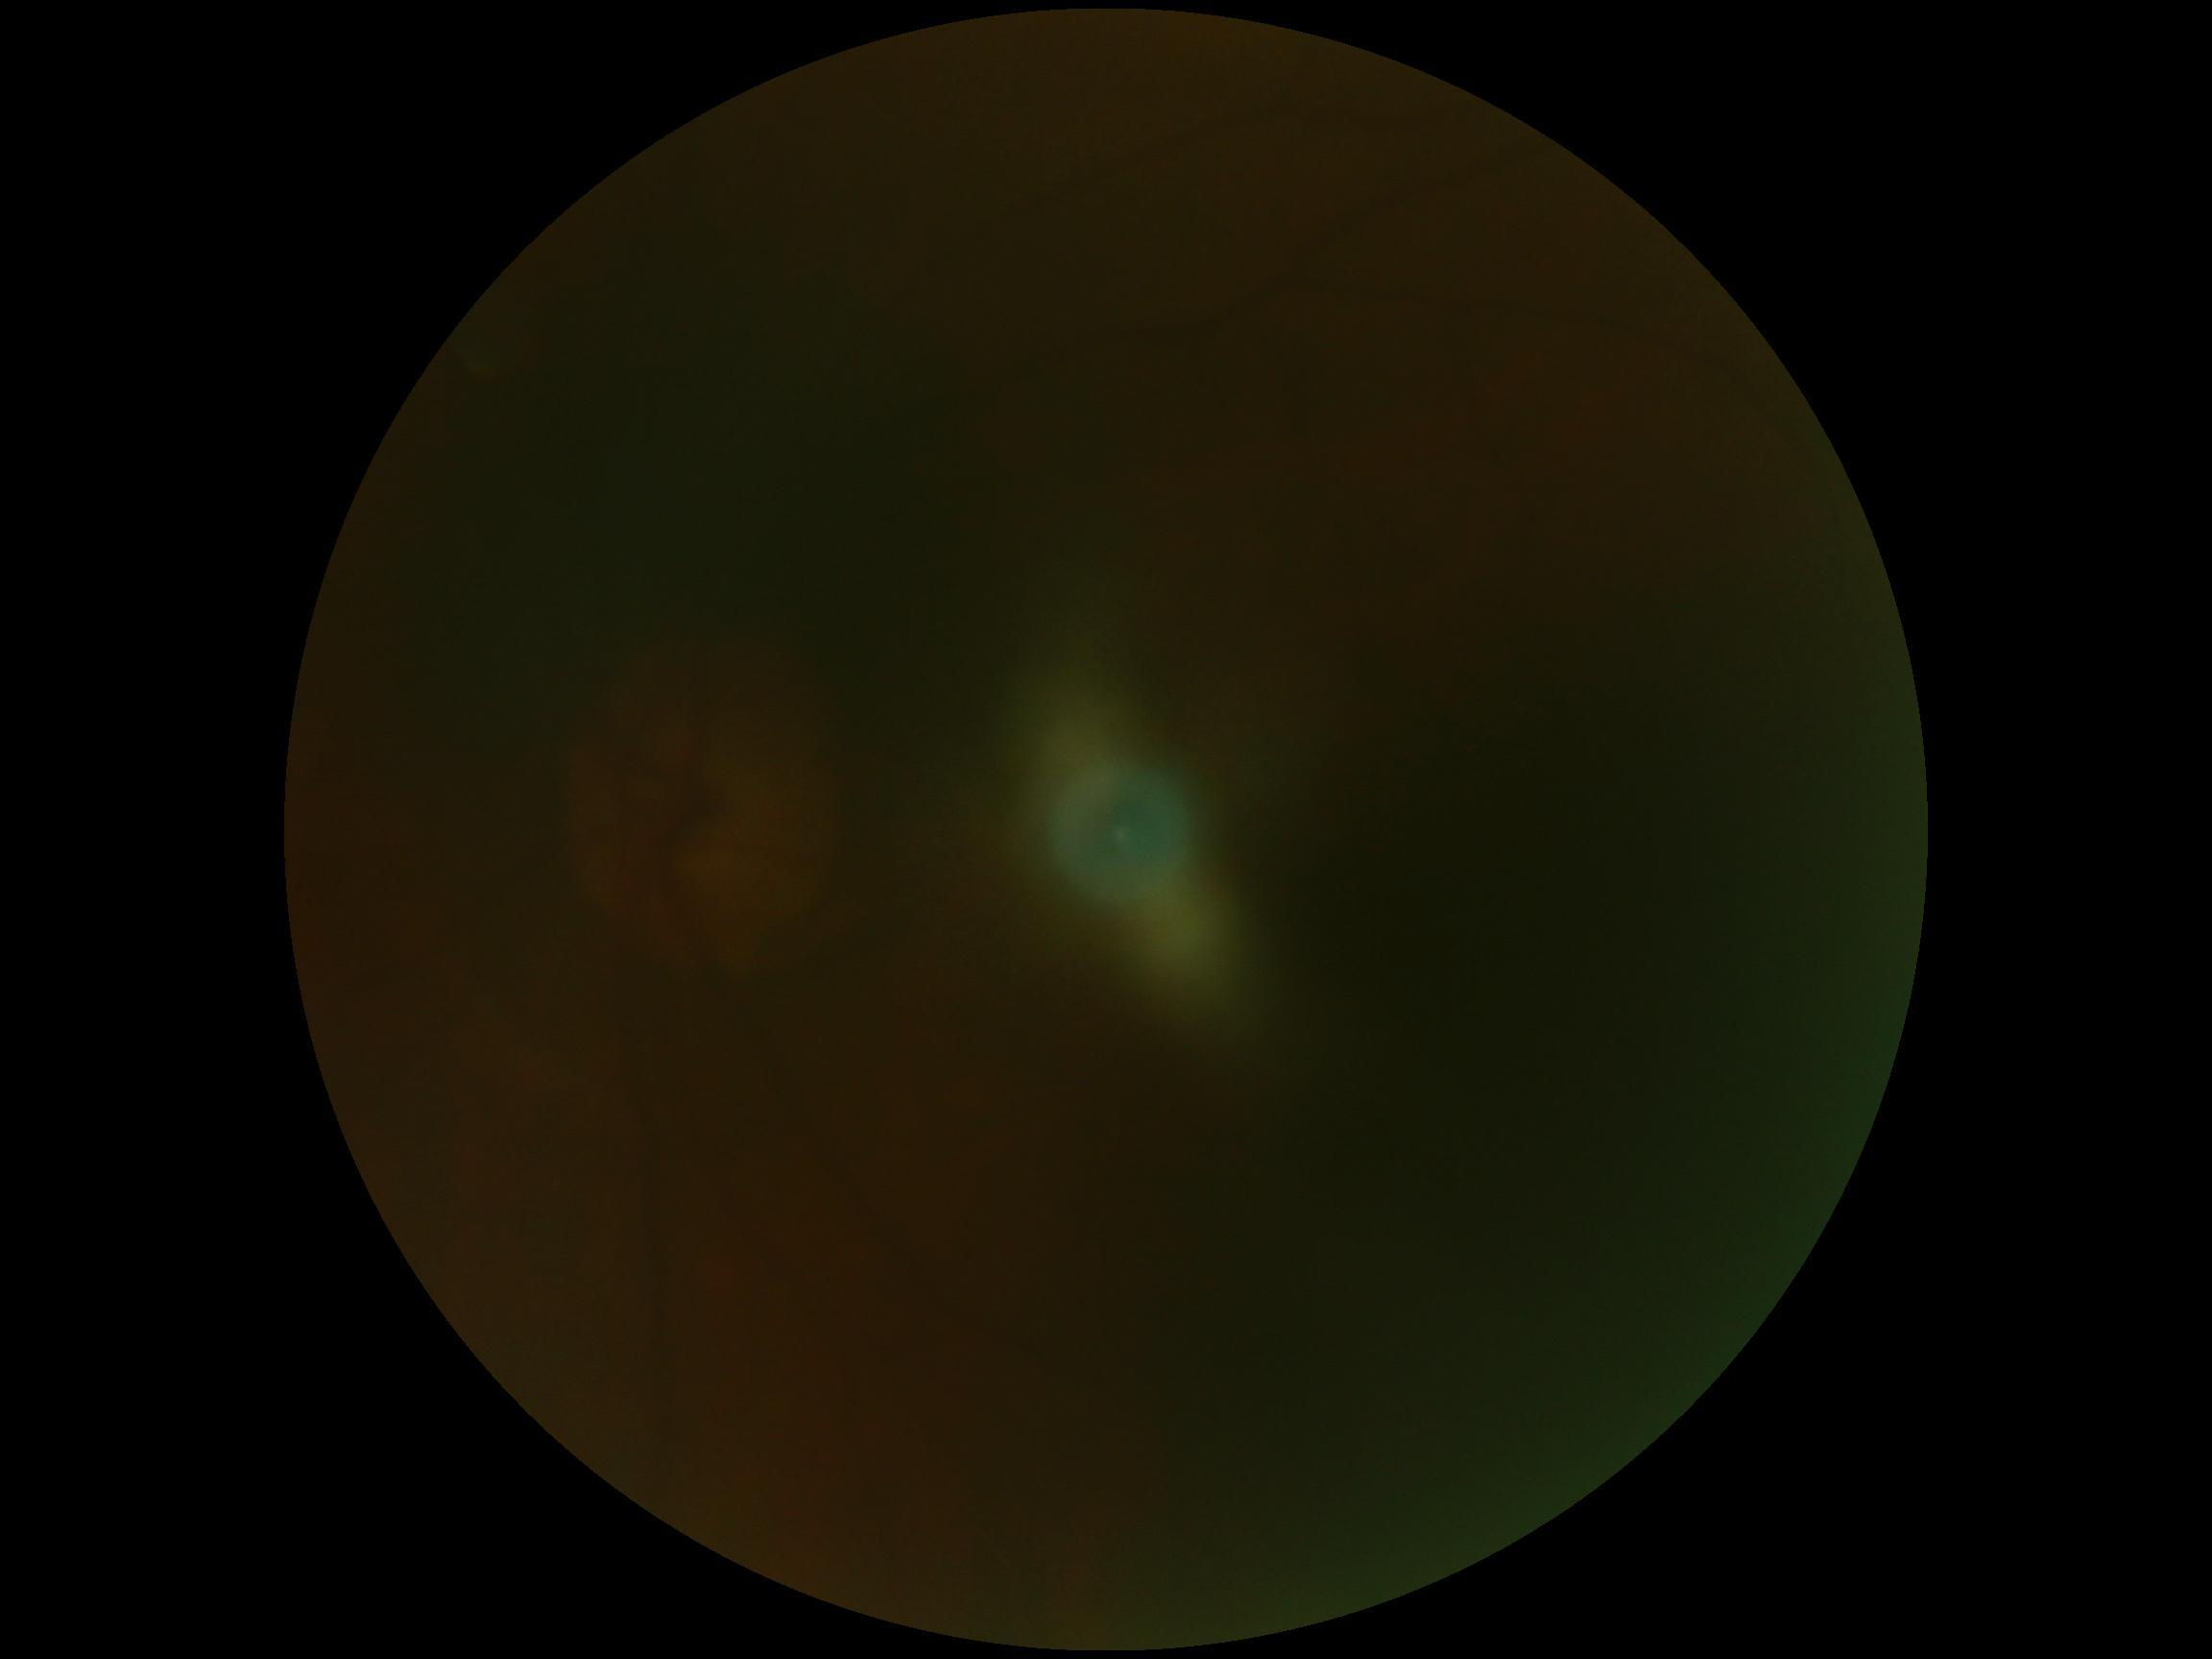

DR grade is ungradable. Ungradable image — DR severity cannot be determined.